2352 x 1568 pixels
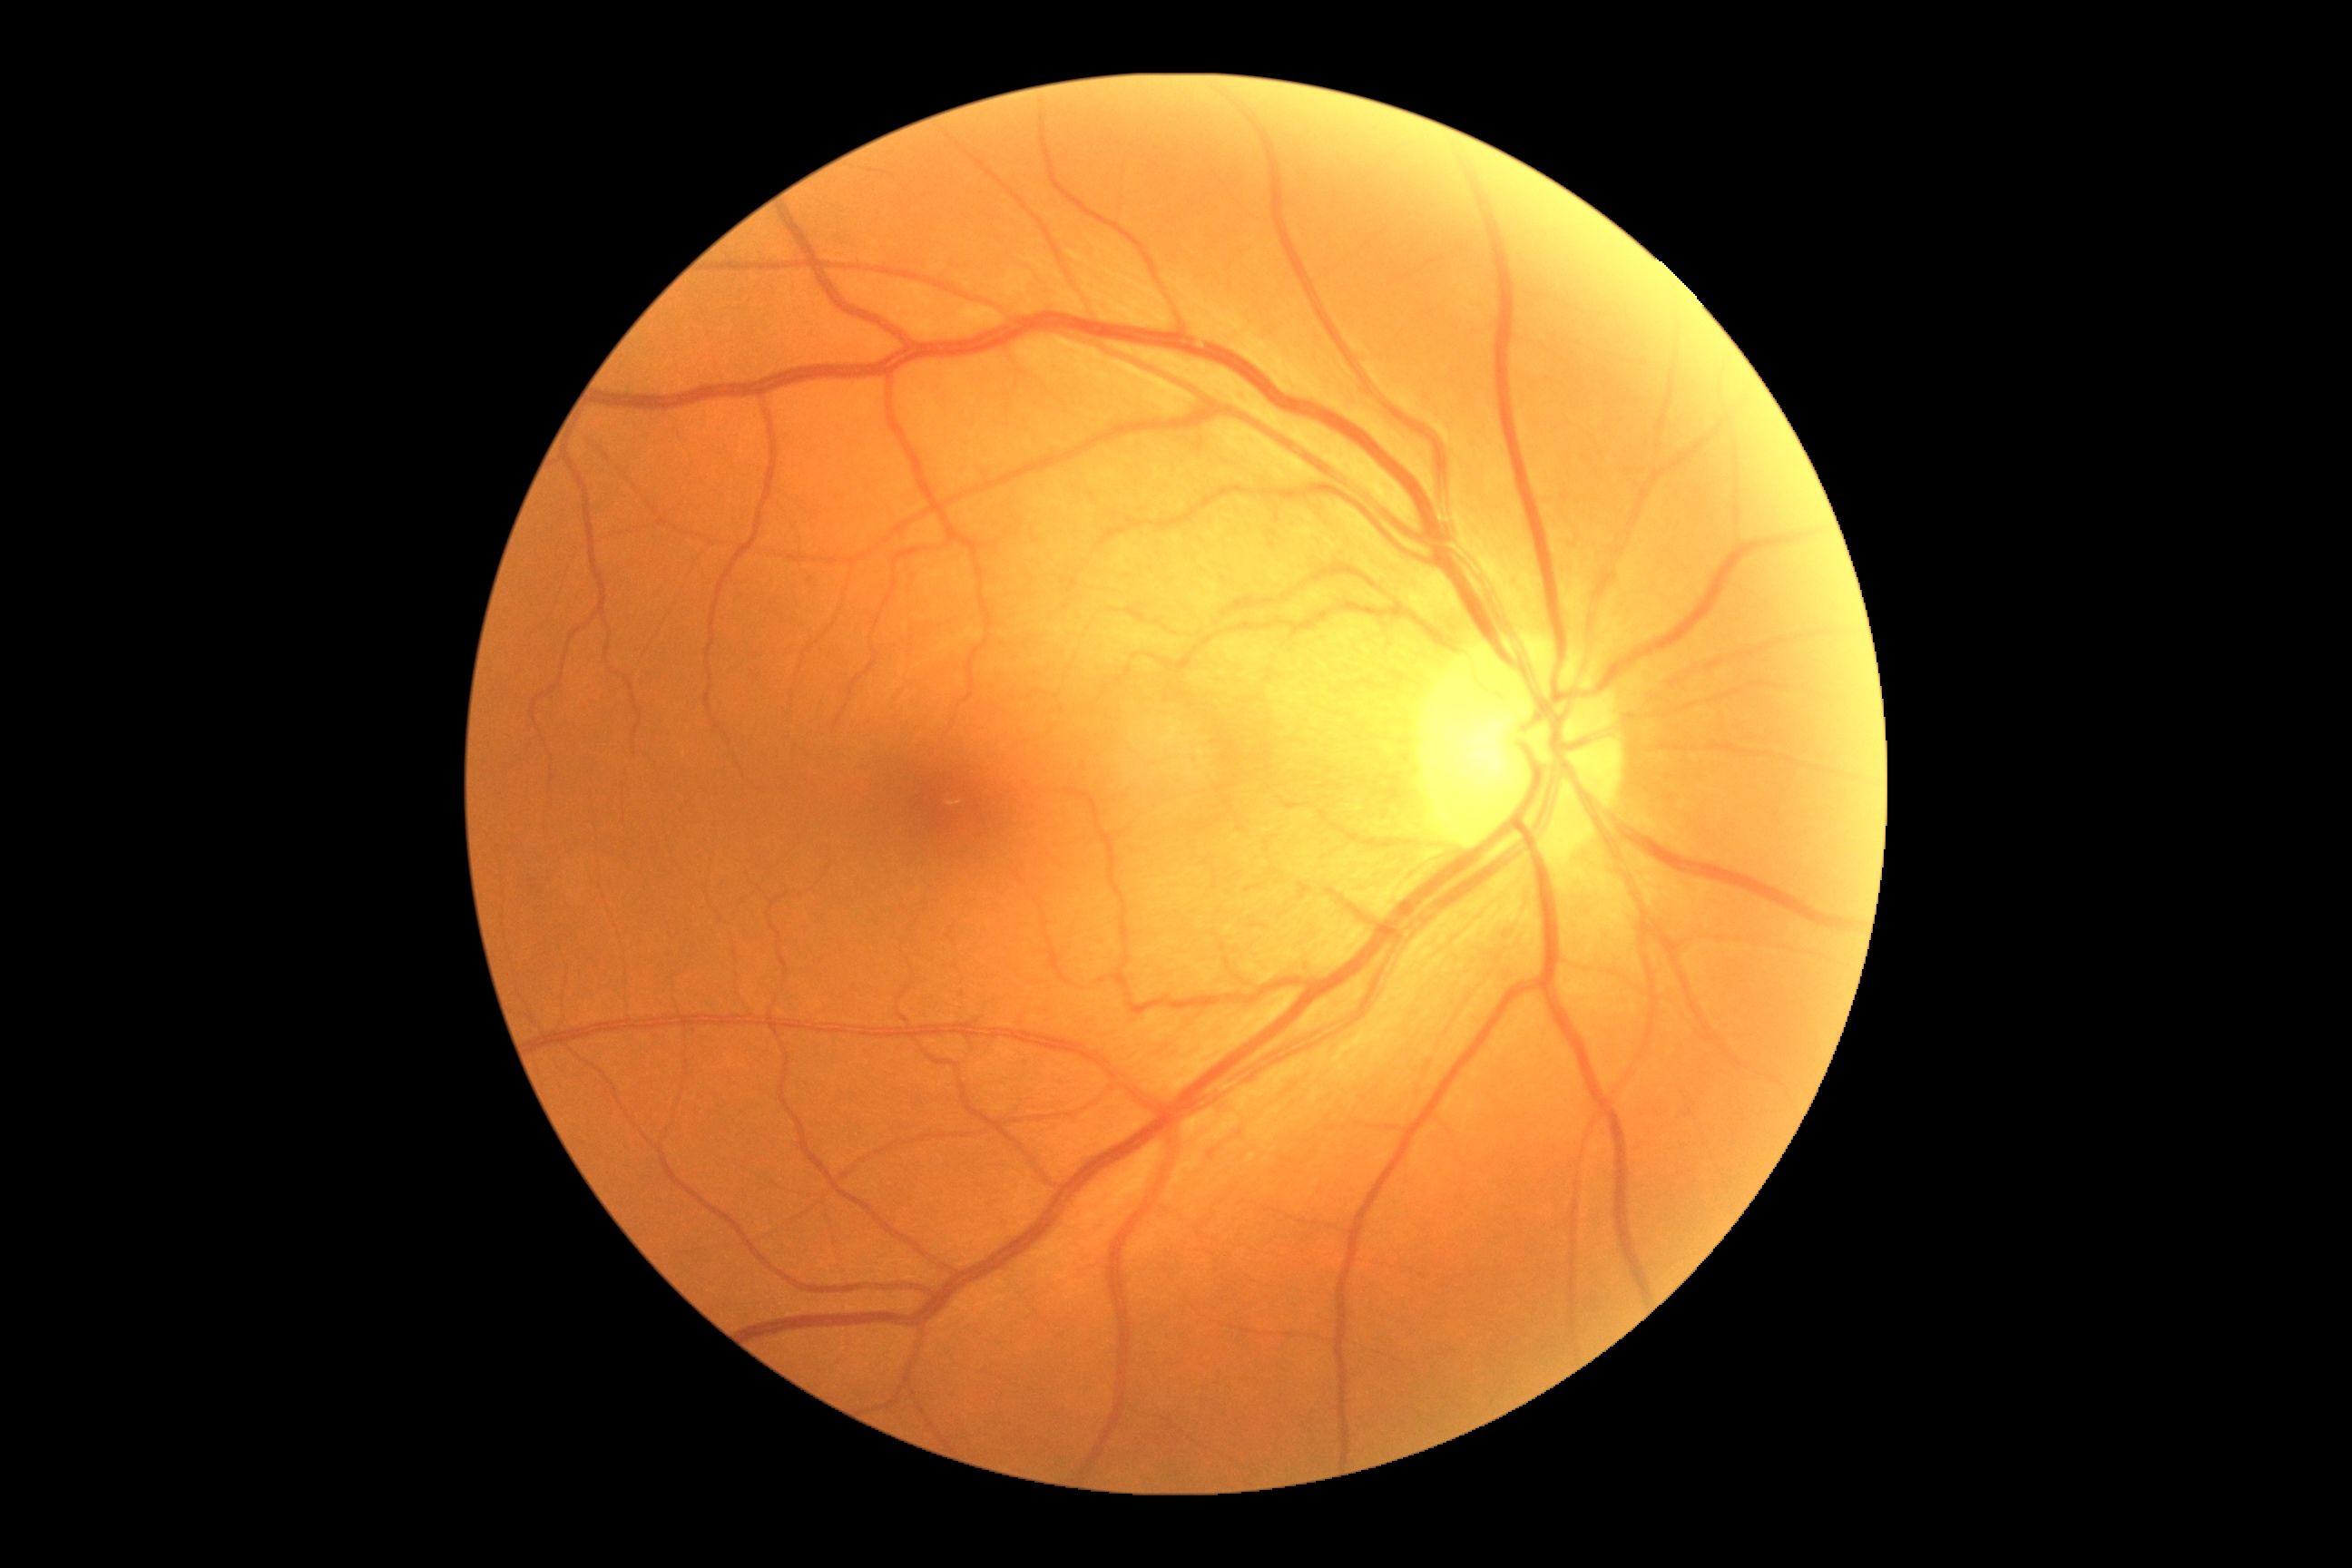
Annotations:
* diabetic retinopathy severity — grade 0
* DR impression — negative for DR